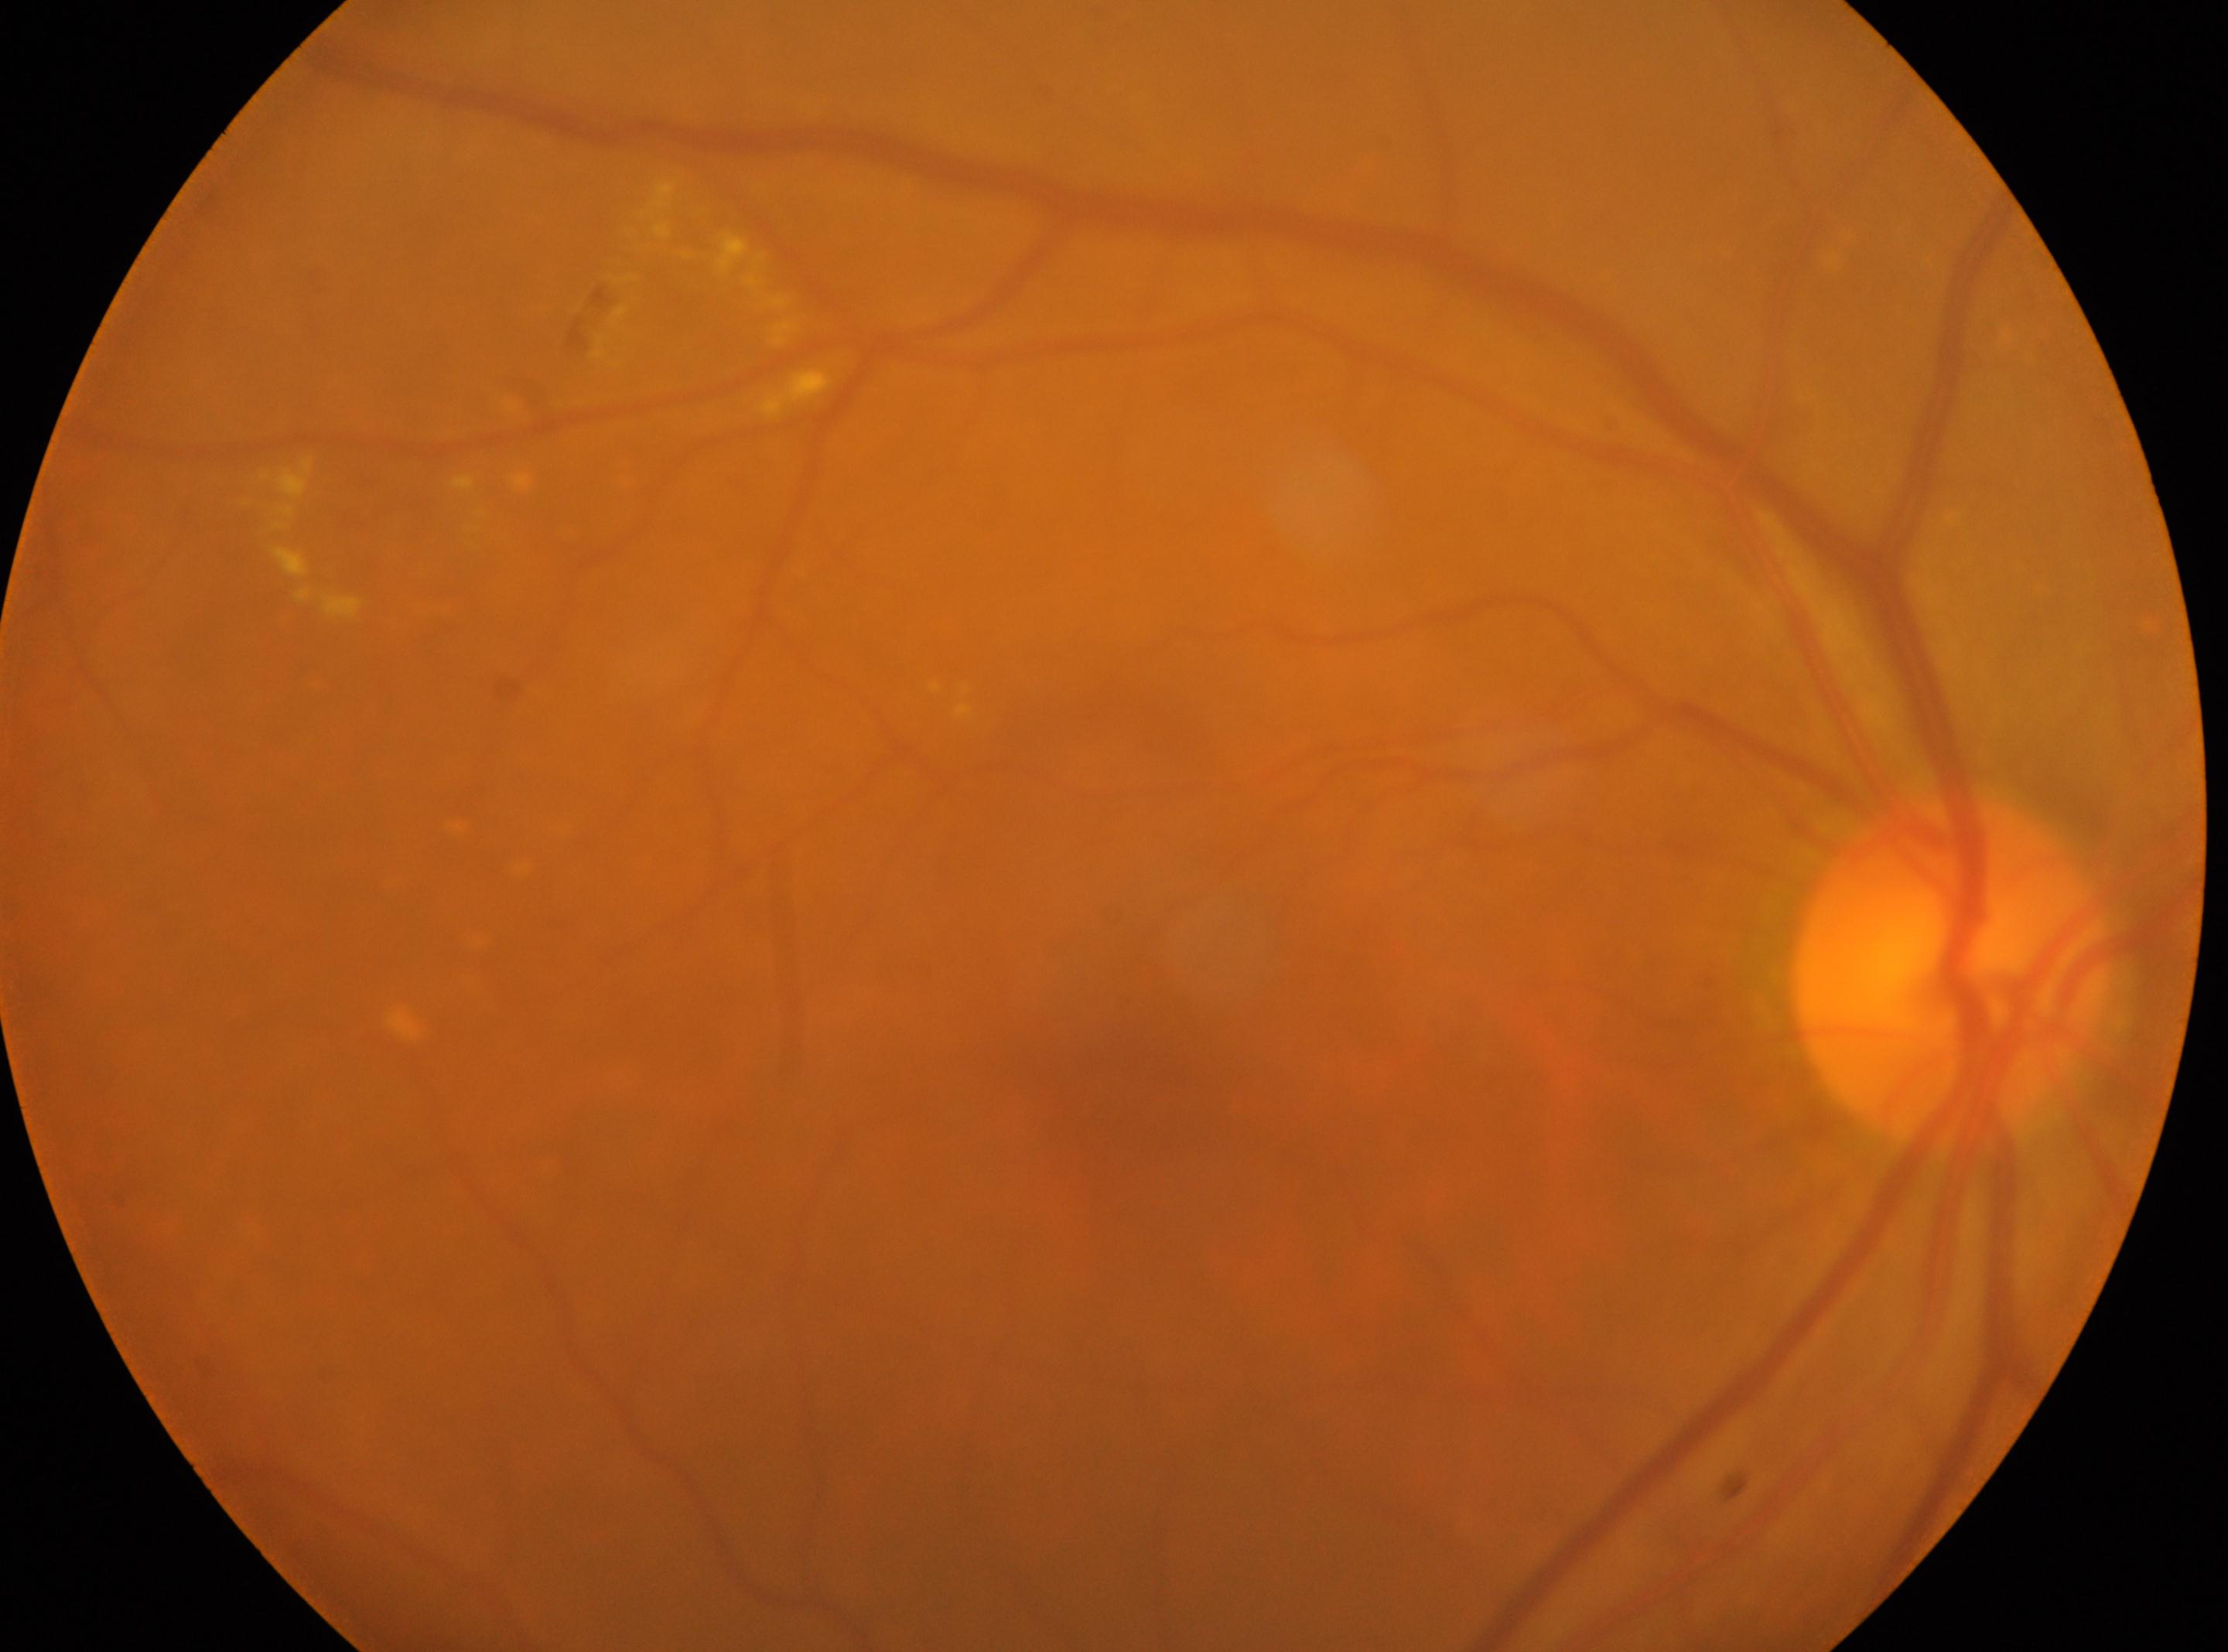
laterality: right | optic nerve head: (1951, 974) | the fovea: (1103, 1103) | diabetic retinopathy (DR): 2.